Pediatric wide-field fundus photograph; captured with the Clarity RetCam 3 (130° field of view): 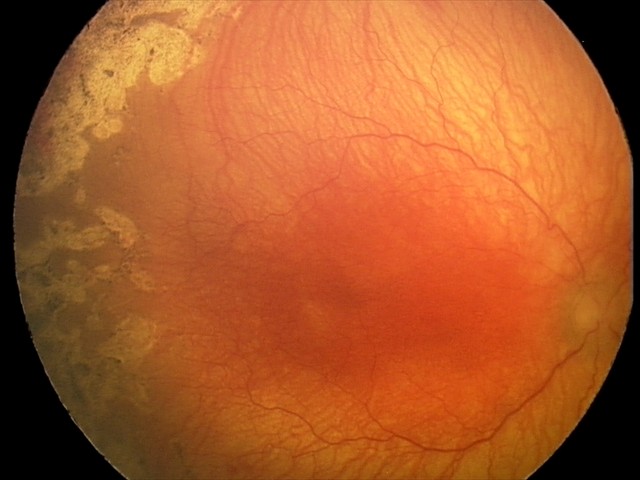

Plus form = present; screening diagnosis = aggressive retinopathy of prematurity.